Color fundus image. Nonmydriatic. 45° field of view. Camera: NIDEK AFC-230
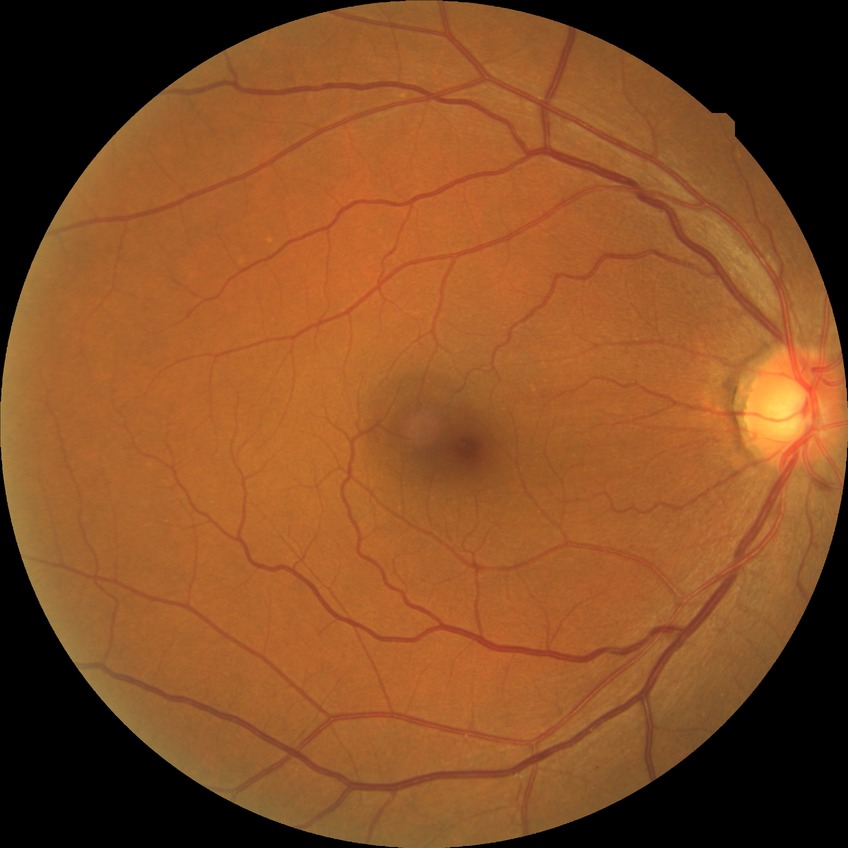

Davis grade: NDR.